2361 by 1568 pixels:
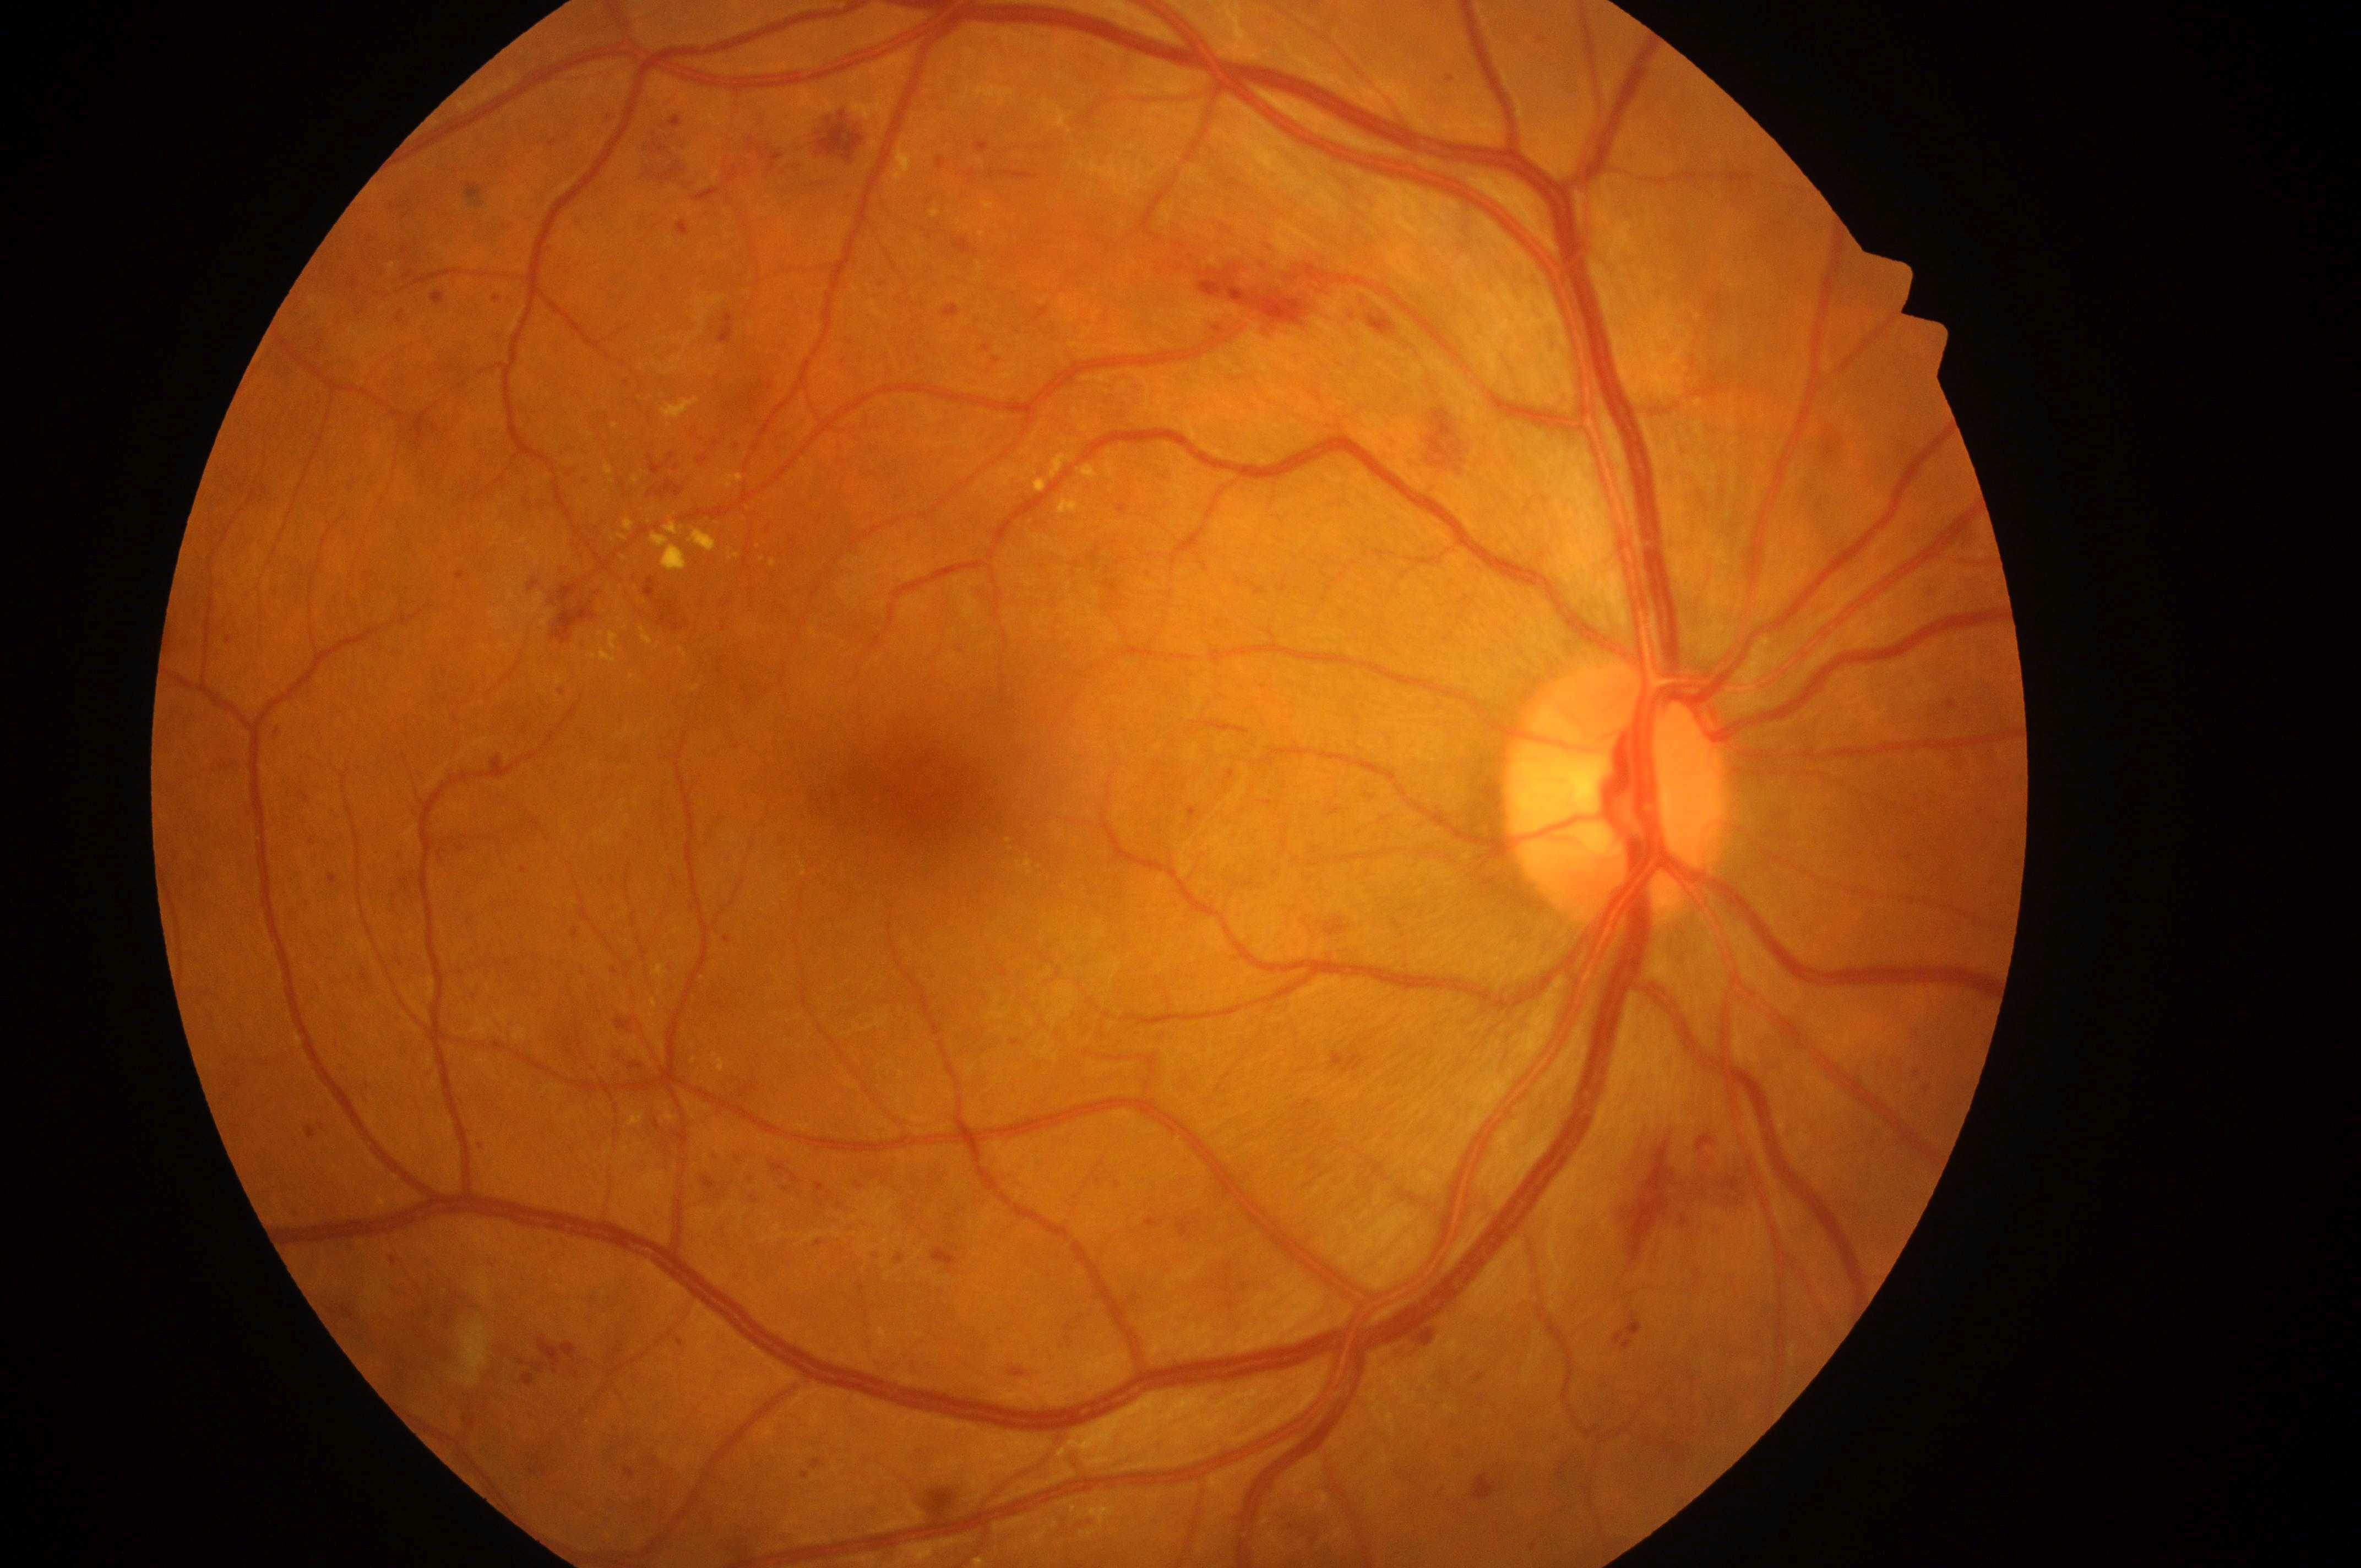
| feature | annotation |
|---|---|
| laterality | oculus dexter |
| fovea center | 932, 781 |
| diabetic retinopathy grade | 3 (severe NPDR) |
| optic disk | 1613, 802 |
| diabetic macular edema | high risk (grade 2) |